Retinal fundus photograph
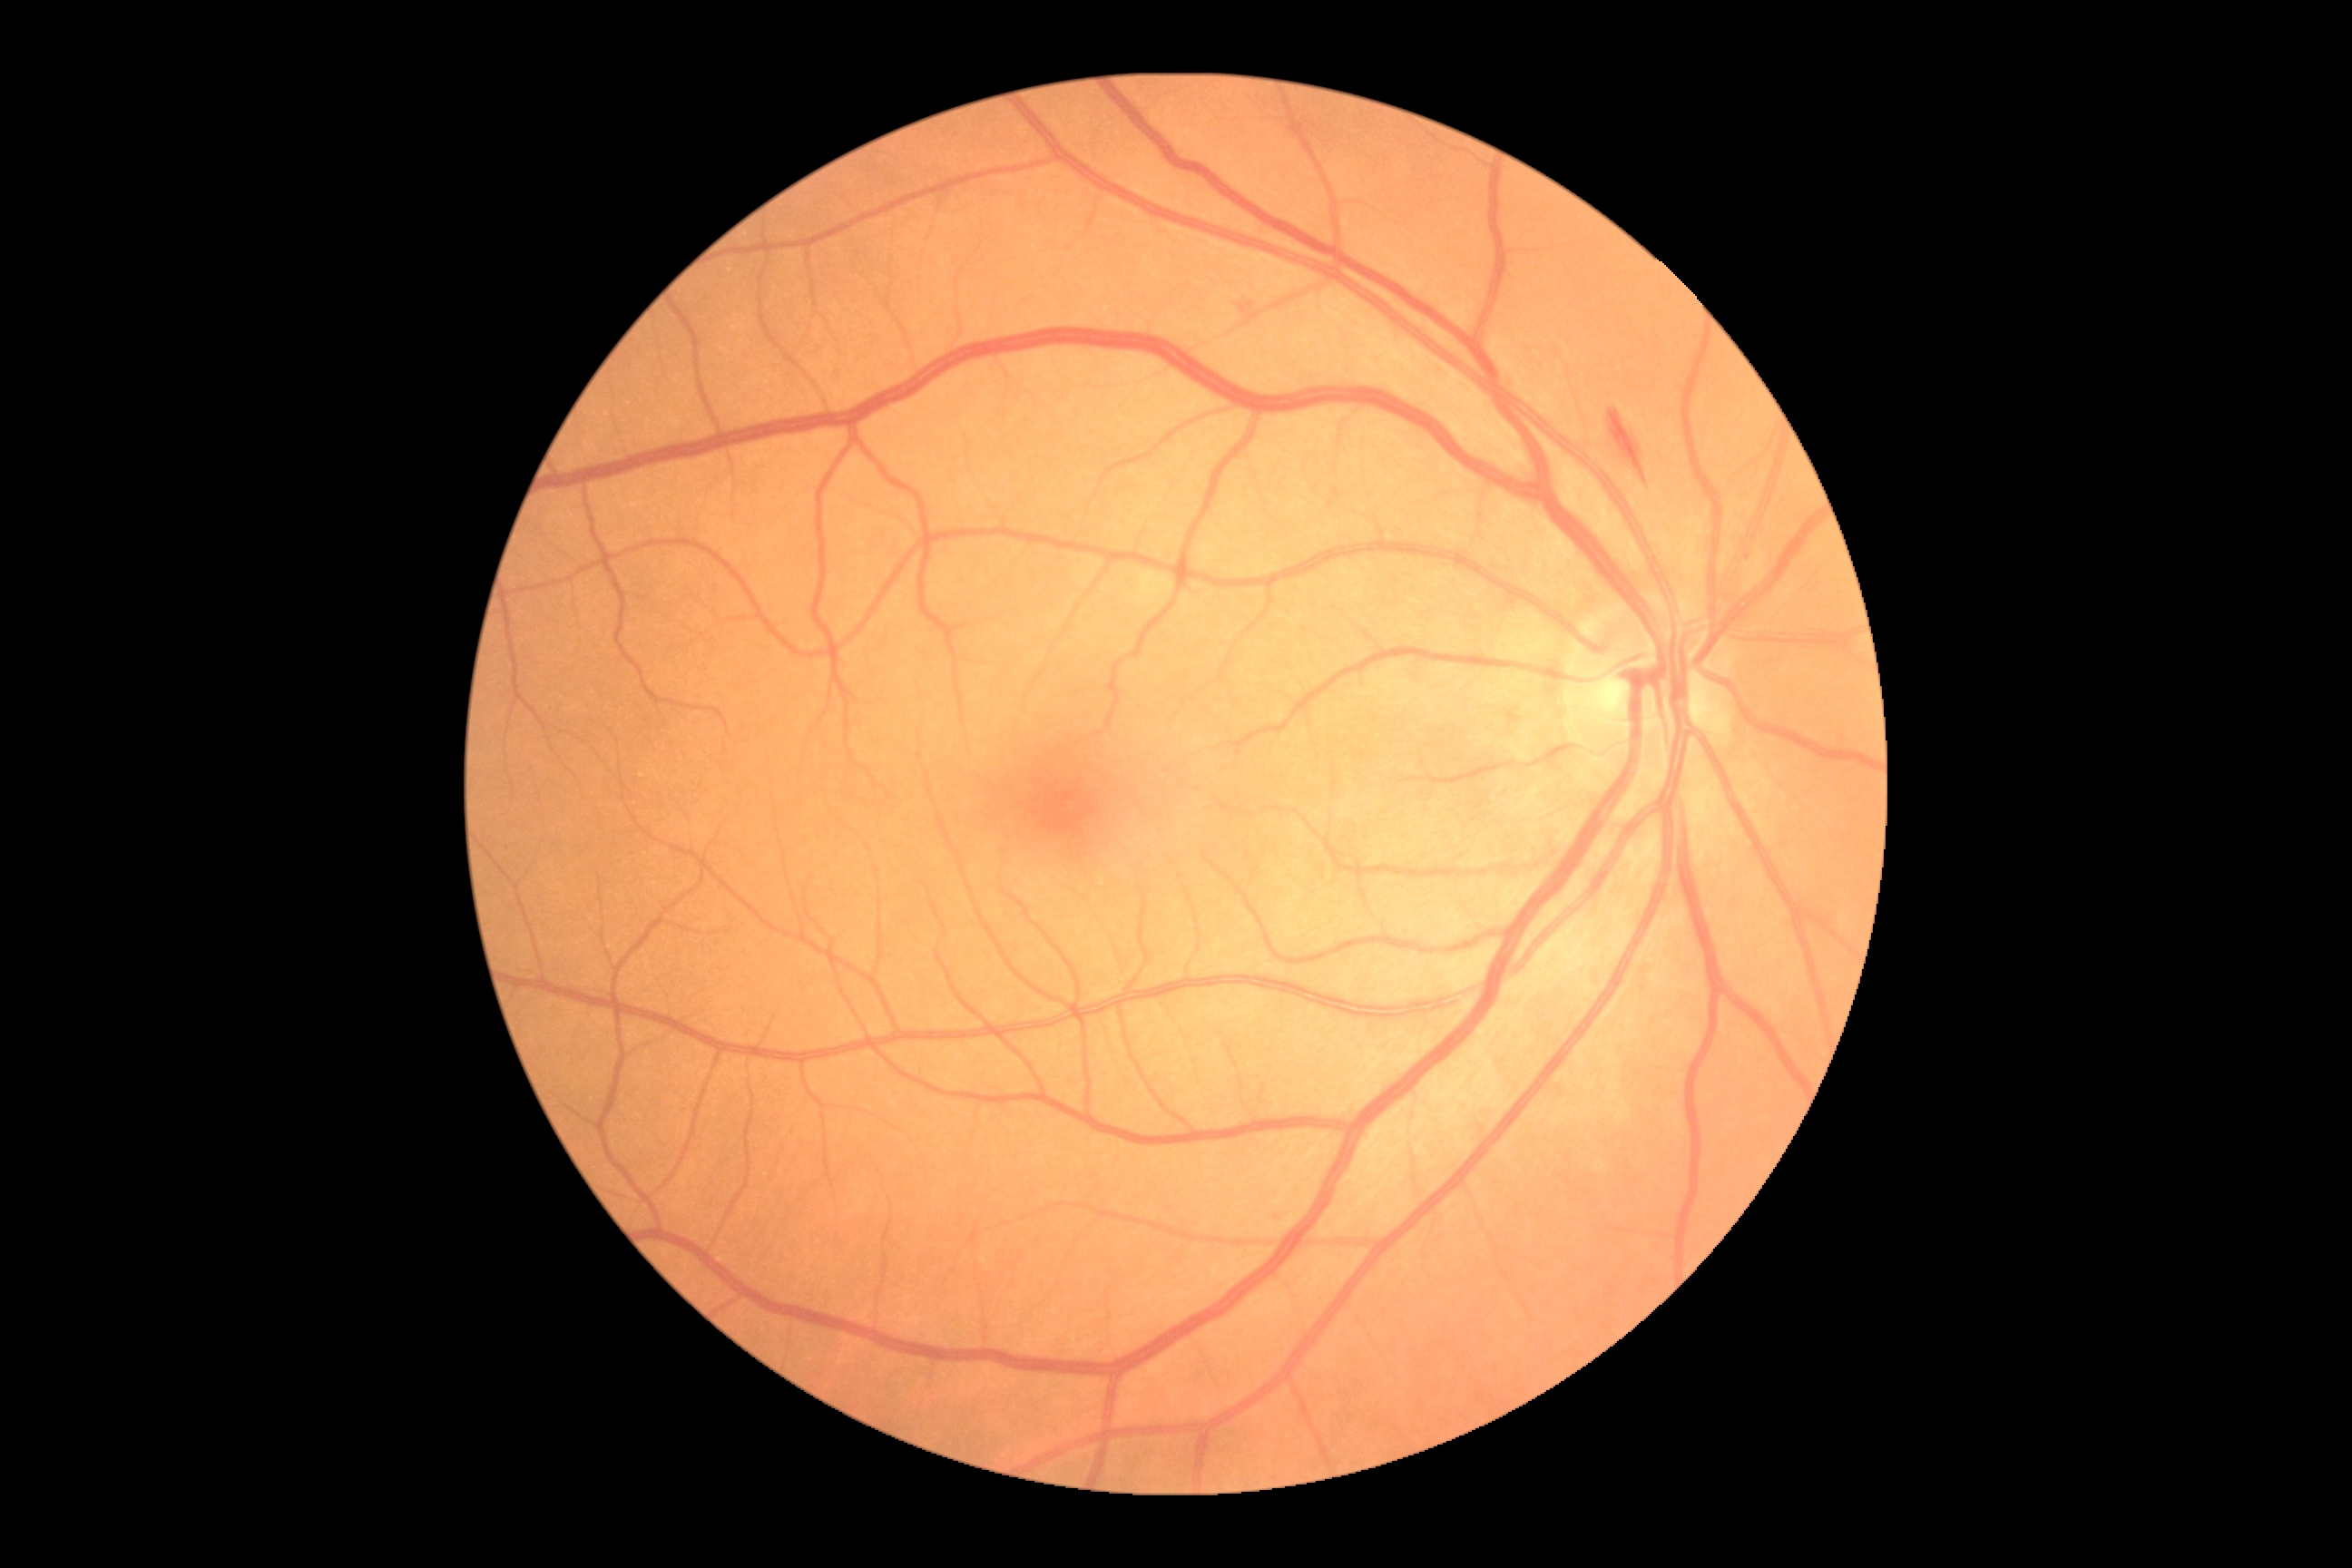

Findings:
• diabetic retinopathy grade — 2/4